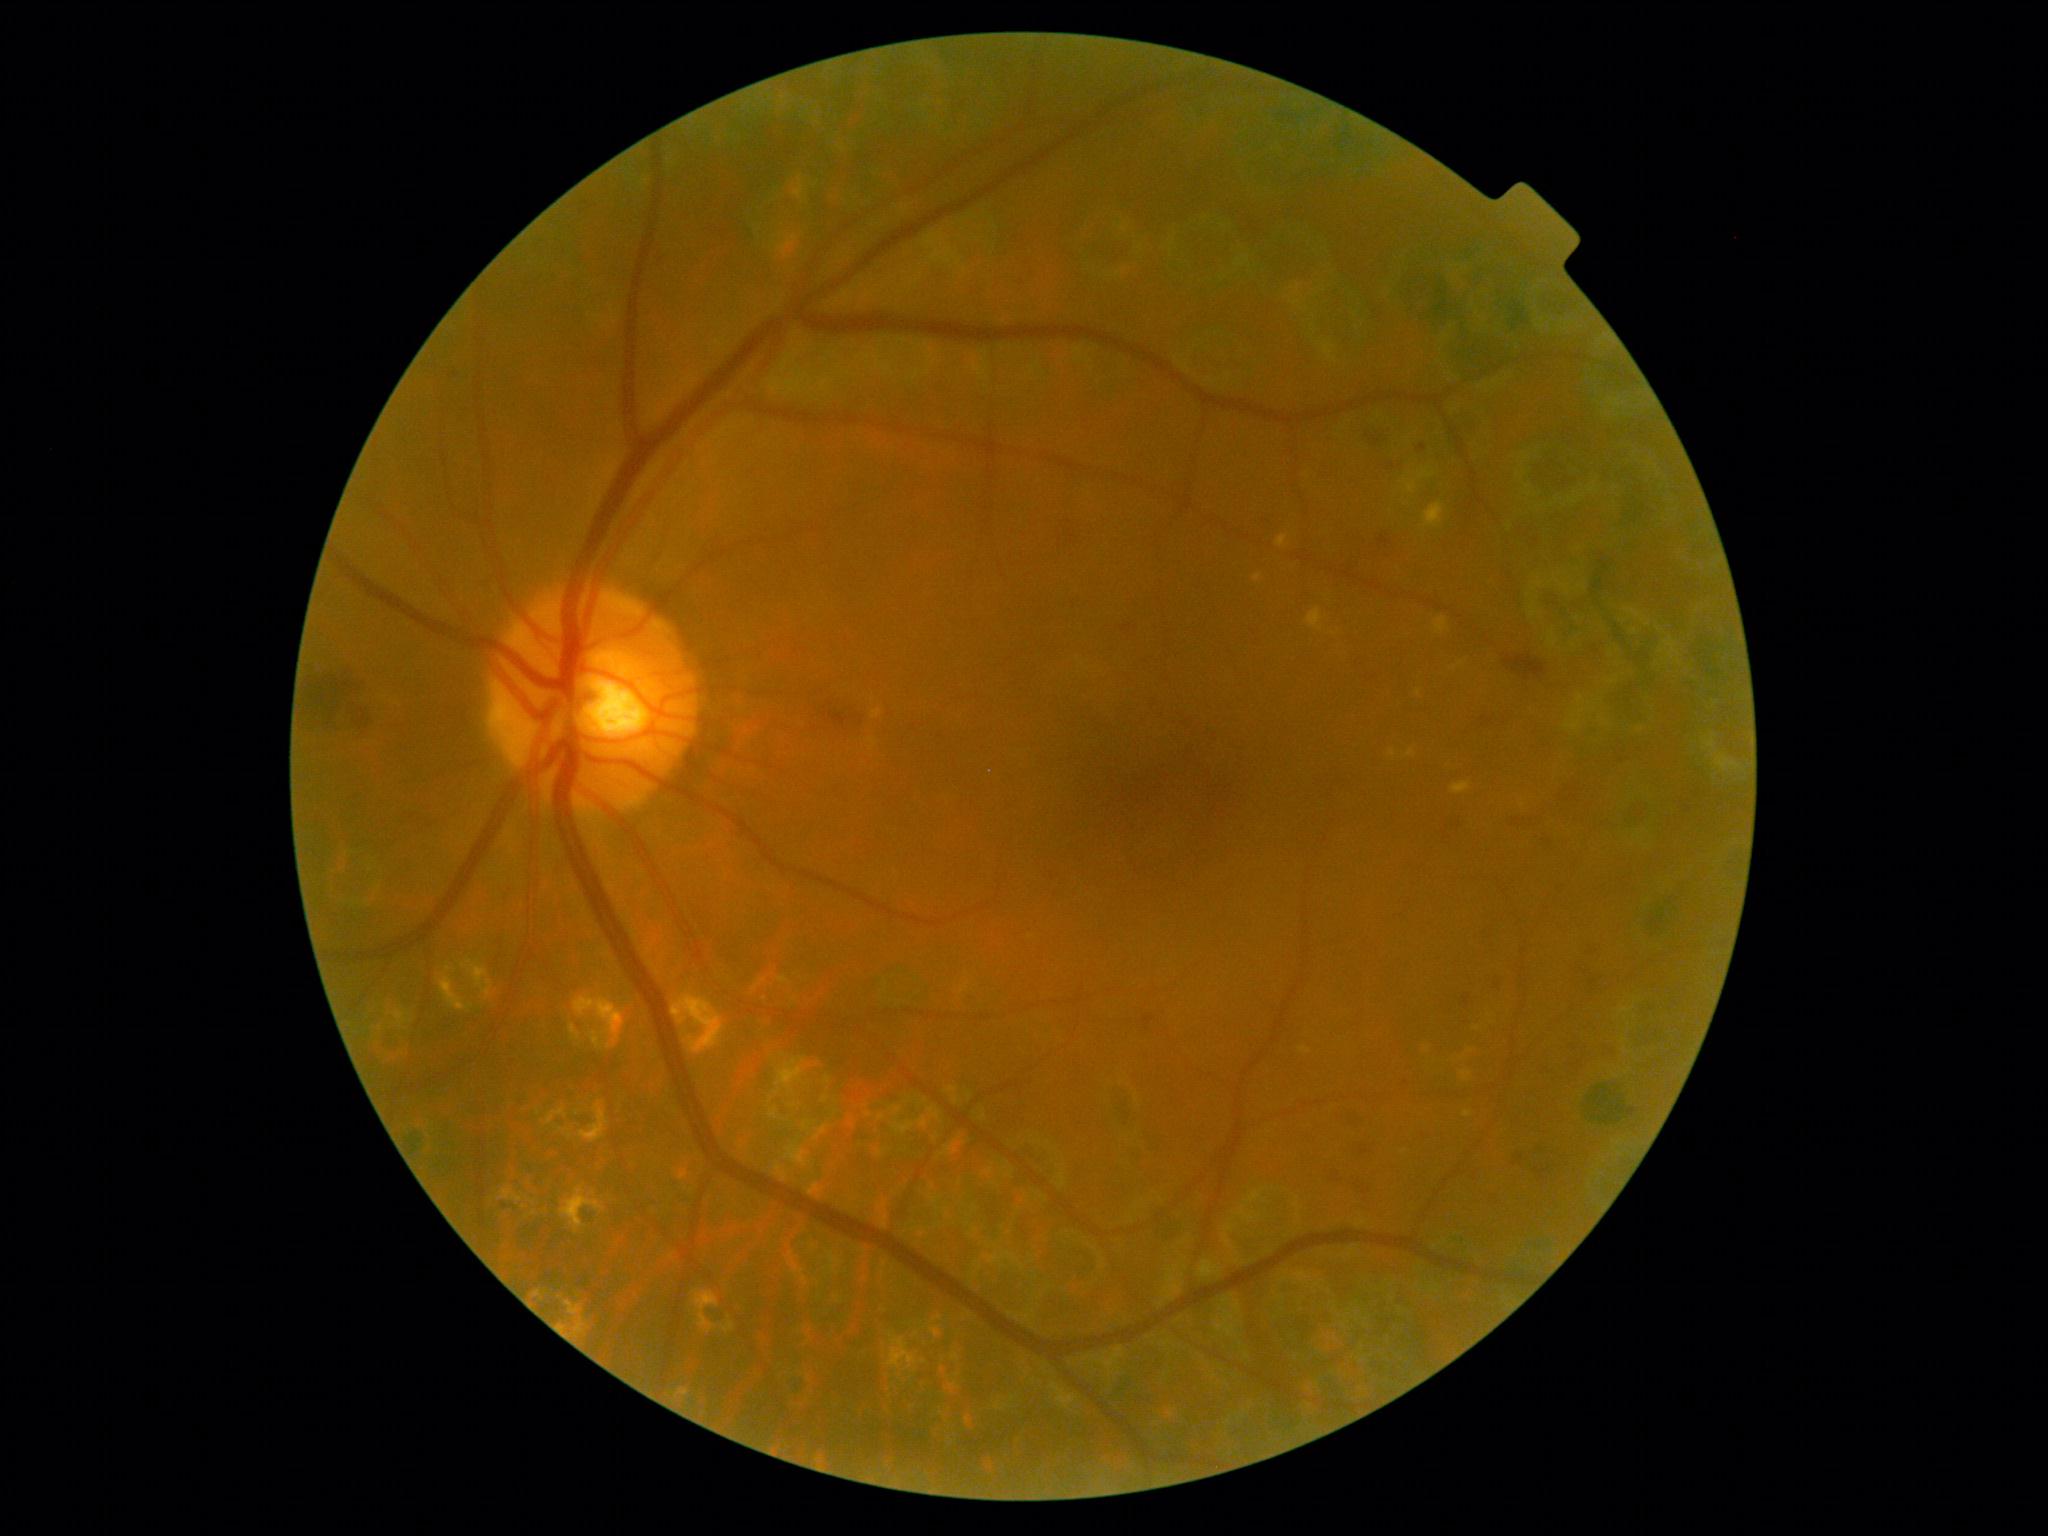 <lesions partial="true">
  <dr_grade>2</dr_grade>
  <he partial="true"><region>1364, 1181, 1376, 1193</region> | <region>1513, 1147, 1529, 1160</region> | <region>1608, 1039, 1614, 1052</region> | <region>1482, 717, 1493, 727</region> | <region>1548, 832, 1553, 845</region> | <region>1563, 1055, 1578, 1068</region> | <region>301, 672, 367, 724</region> | <region>1444, 819, 1466, 829</region> | <region>1493, 978, 1506, 991</region> | <region>1357, 1138, 1373, 1154</region> | <region>1064, 526, 1079, 551</region> | <region>1365, 430, 1387, 449</region></he>
  <ex partial="true"><region>1460, 1071, 1472, 1081</region> | <region>1277, 535, 1288, 548</region> | <region>1390, 750, 1397, 759</region> | <region>1424, 502, 1444, 529</region> | <region>1254, 575, 1262, 582</region> | <region>1463, 1111, 1473, 1118</region> | <region>1434, 616, 1449, 635</region> | <region>1403, 477, 1419, 495</region> | <region>872, 710, 882, 720</region> | <region>1452, 781, 1472, 794</region> | <region>1300, 1047, 1312, 1054</region> | <region>1307, 608, 1324, 631</region> | <region>1407, 749, 1416, 757</region> | <region>1467, 1048, 1475, 1054</region></ex>
  <ex_small><pt>1477,1029</pt> | <pt>1404,1152</pt> | <pt>1418,693</pt> | <pt>1427,1050</pt></ex_small>
  <ma><region>1417, 444, 1427, 452</region></ma>
  <ma_small><pt>662,260</pt></ma_small>
  <se />
</lesions>